Without pupil dilation; 848 x 848 pixels; 45 degree fundus photograph — 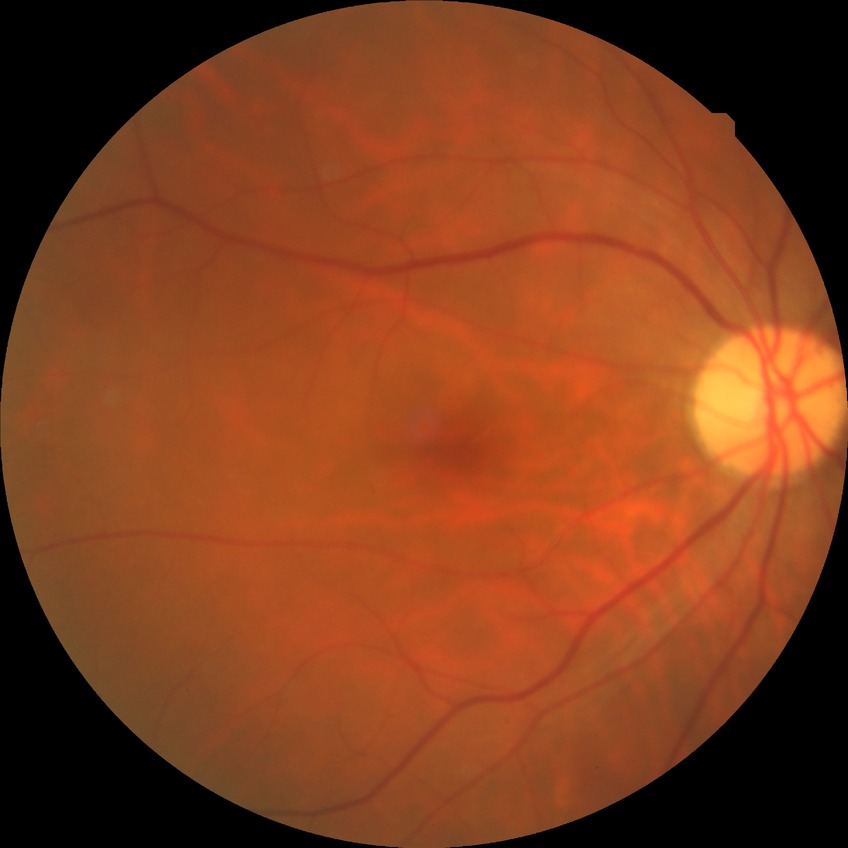
{"davis_grade": "no diabetic retinopathy"}